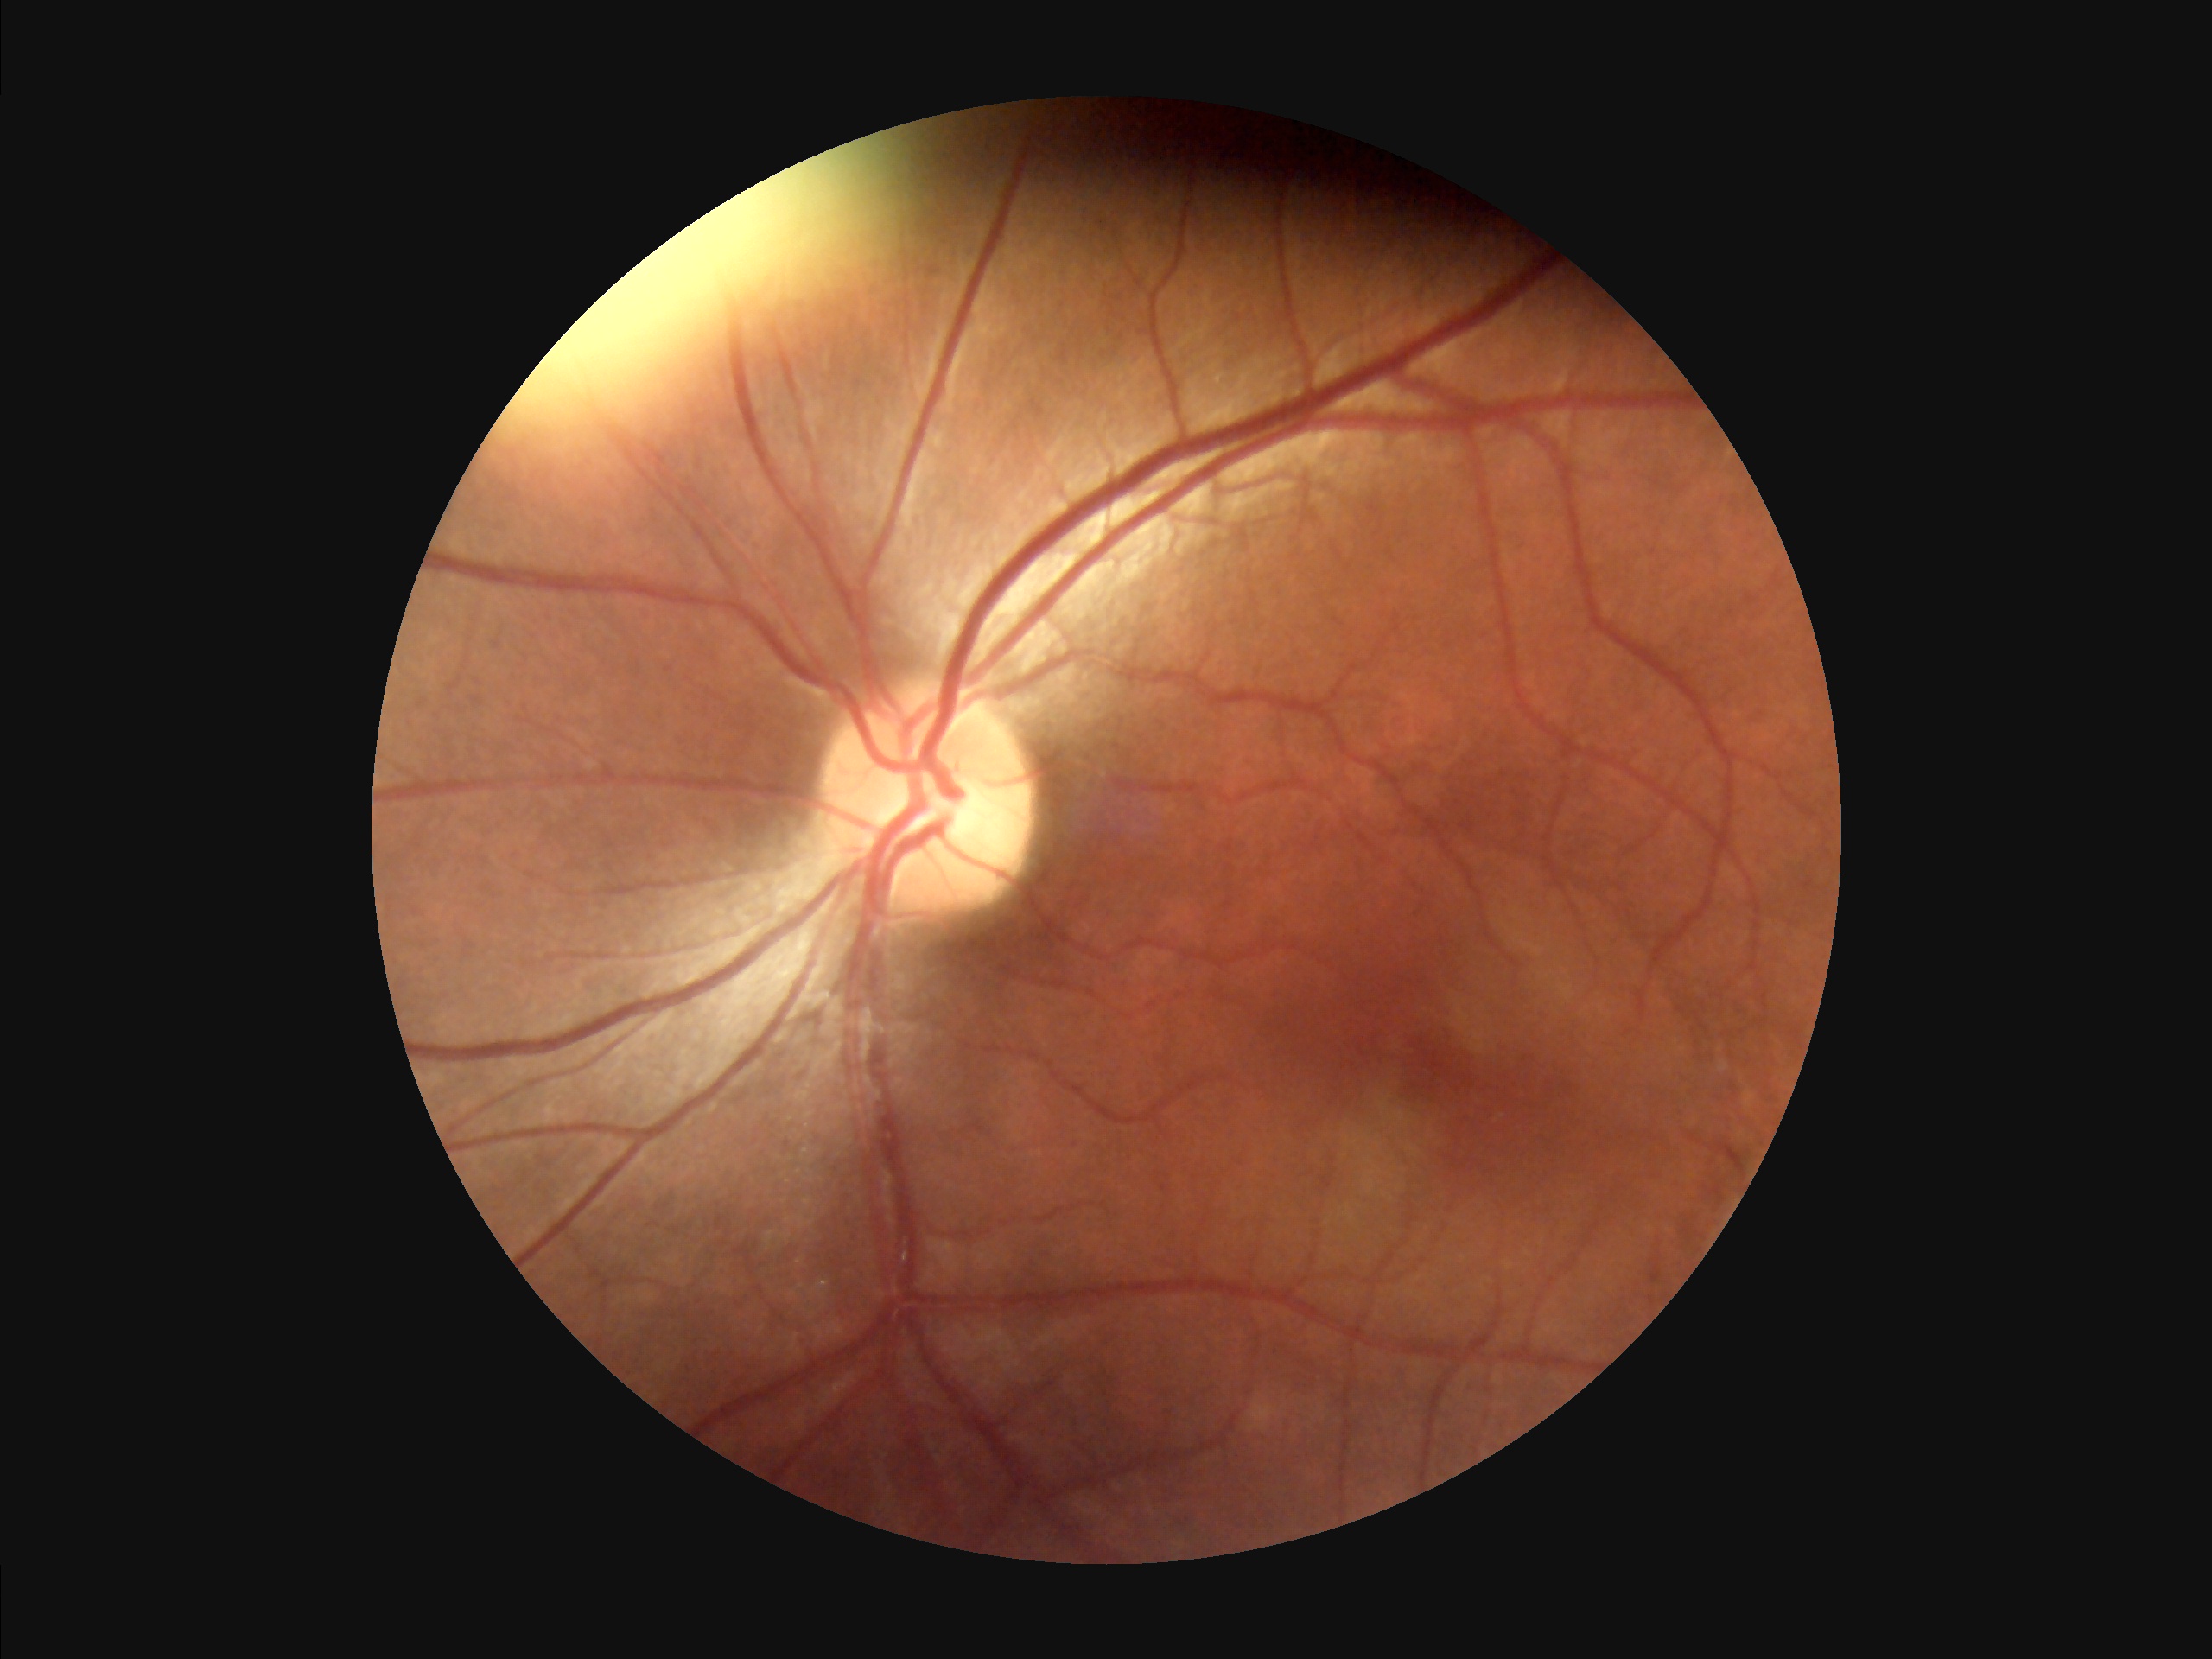
Overall image quality = acceptable; Sharpness = clear; Illumination = uneven.